Infant wide-field fundus photograph: 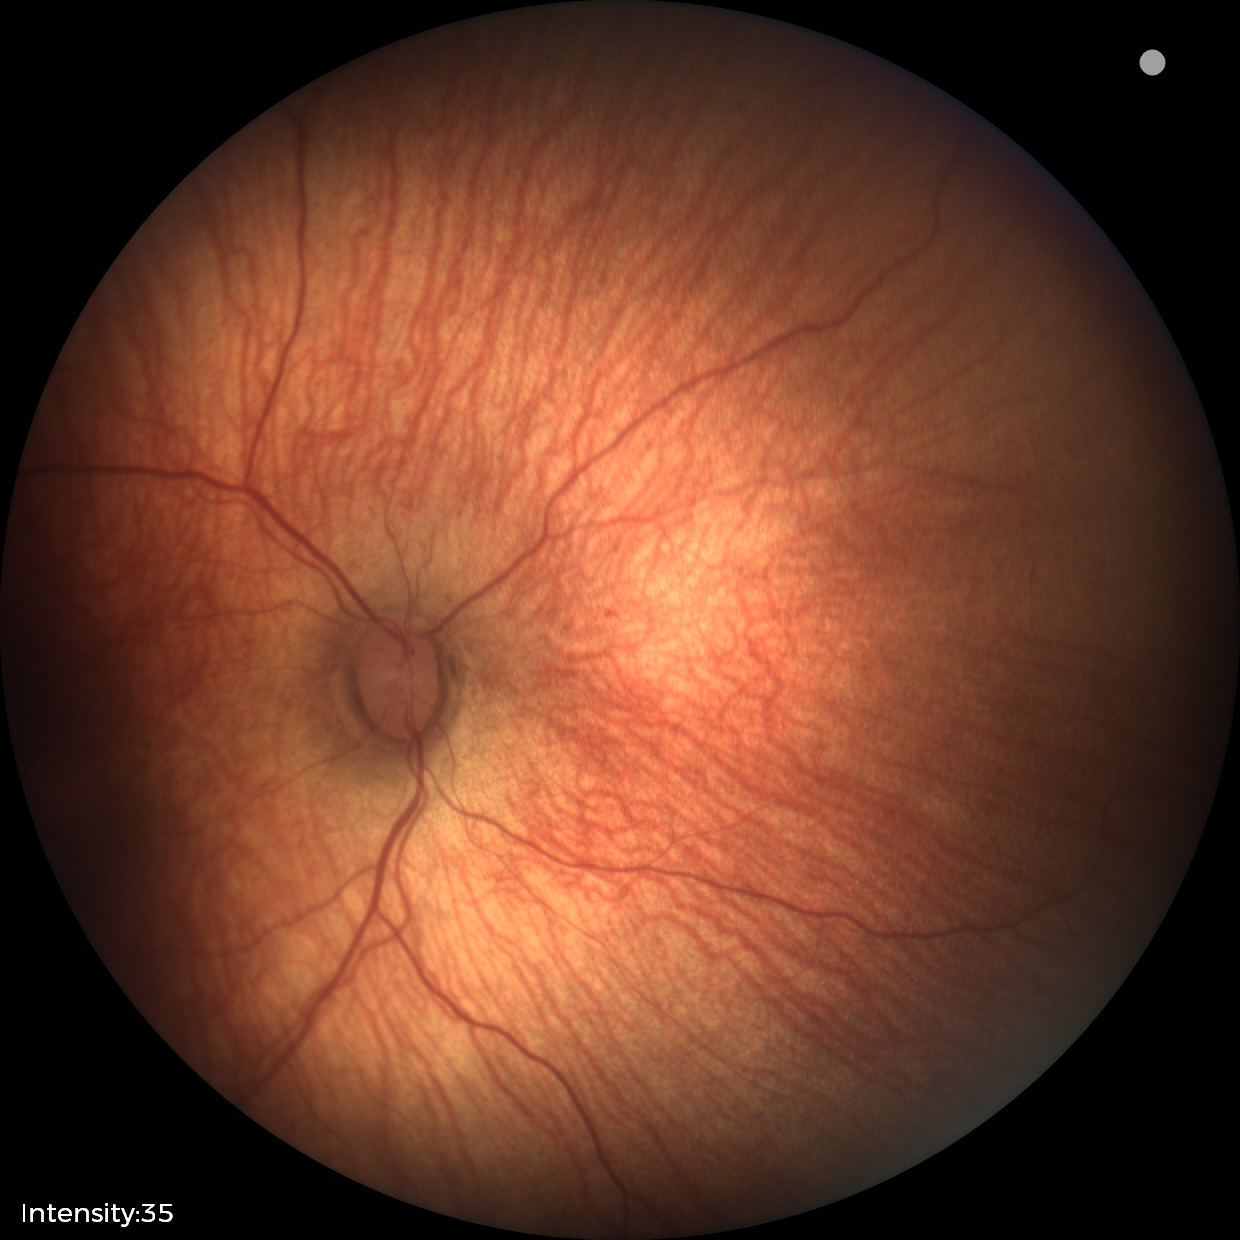
No plus disease.
Diagnosis from this screening exam: status post ROP.